2212x1659px · color fundus photograph.
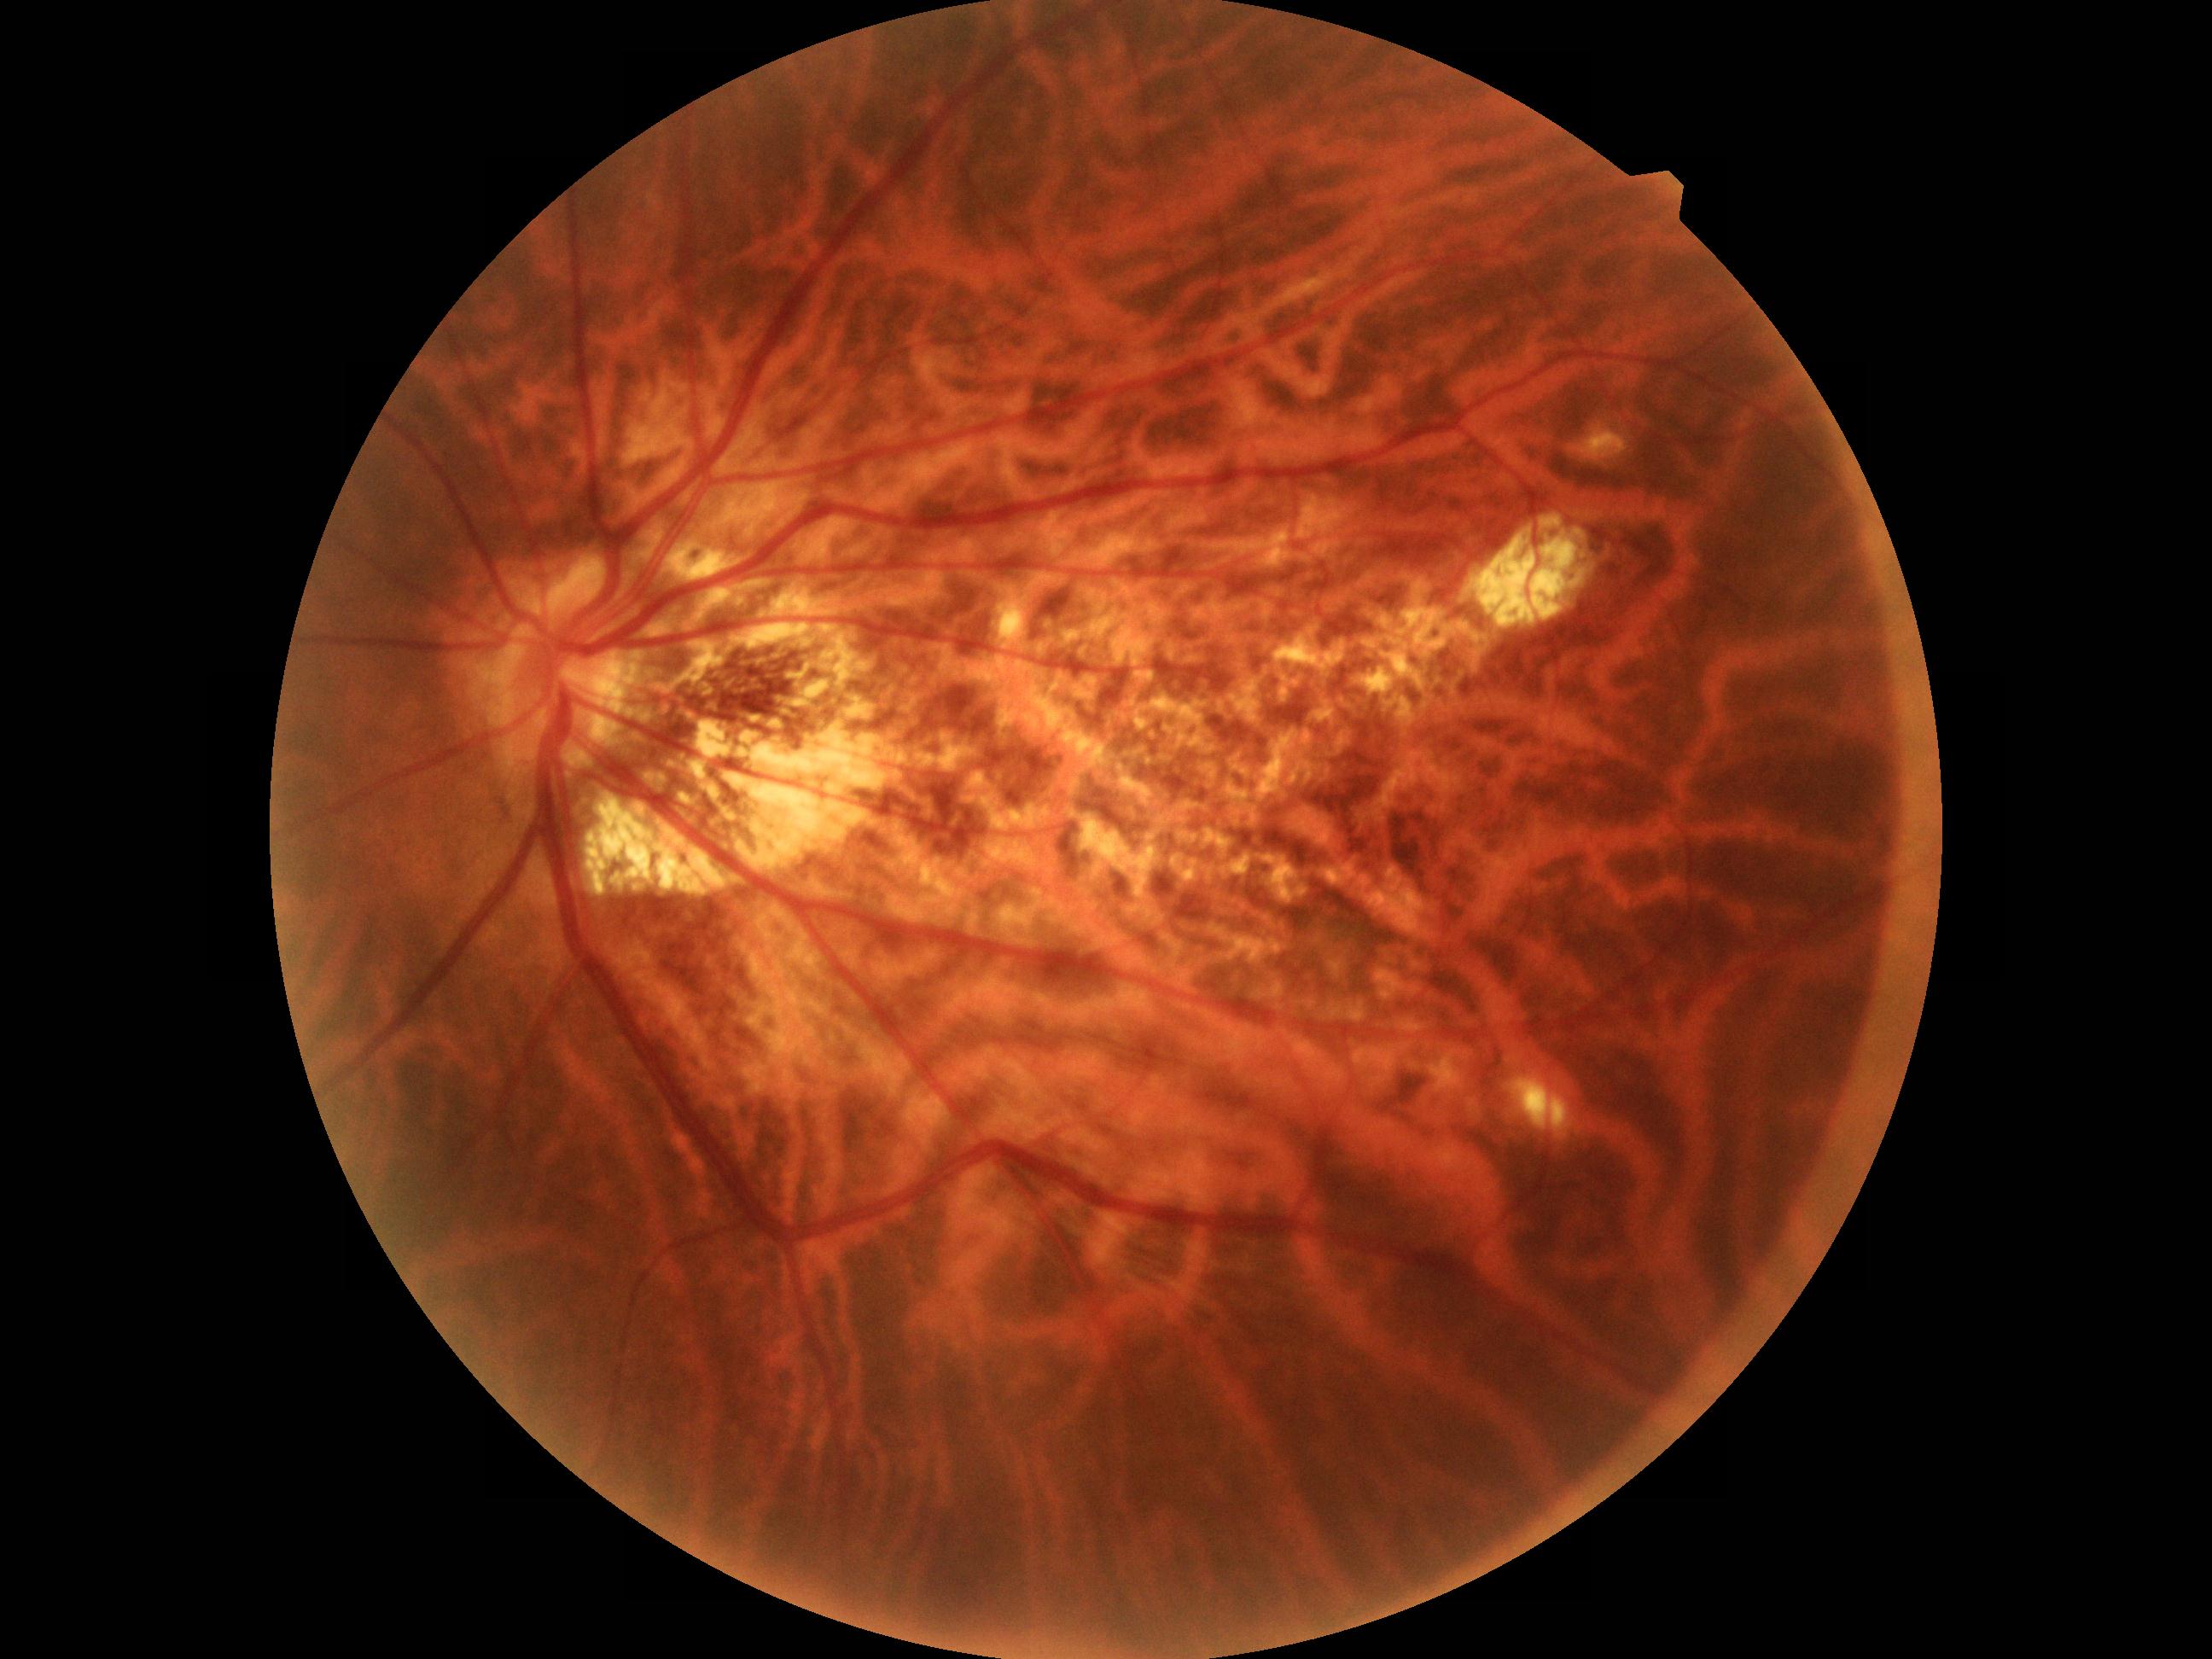

Primary finding: pathological myopia.